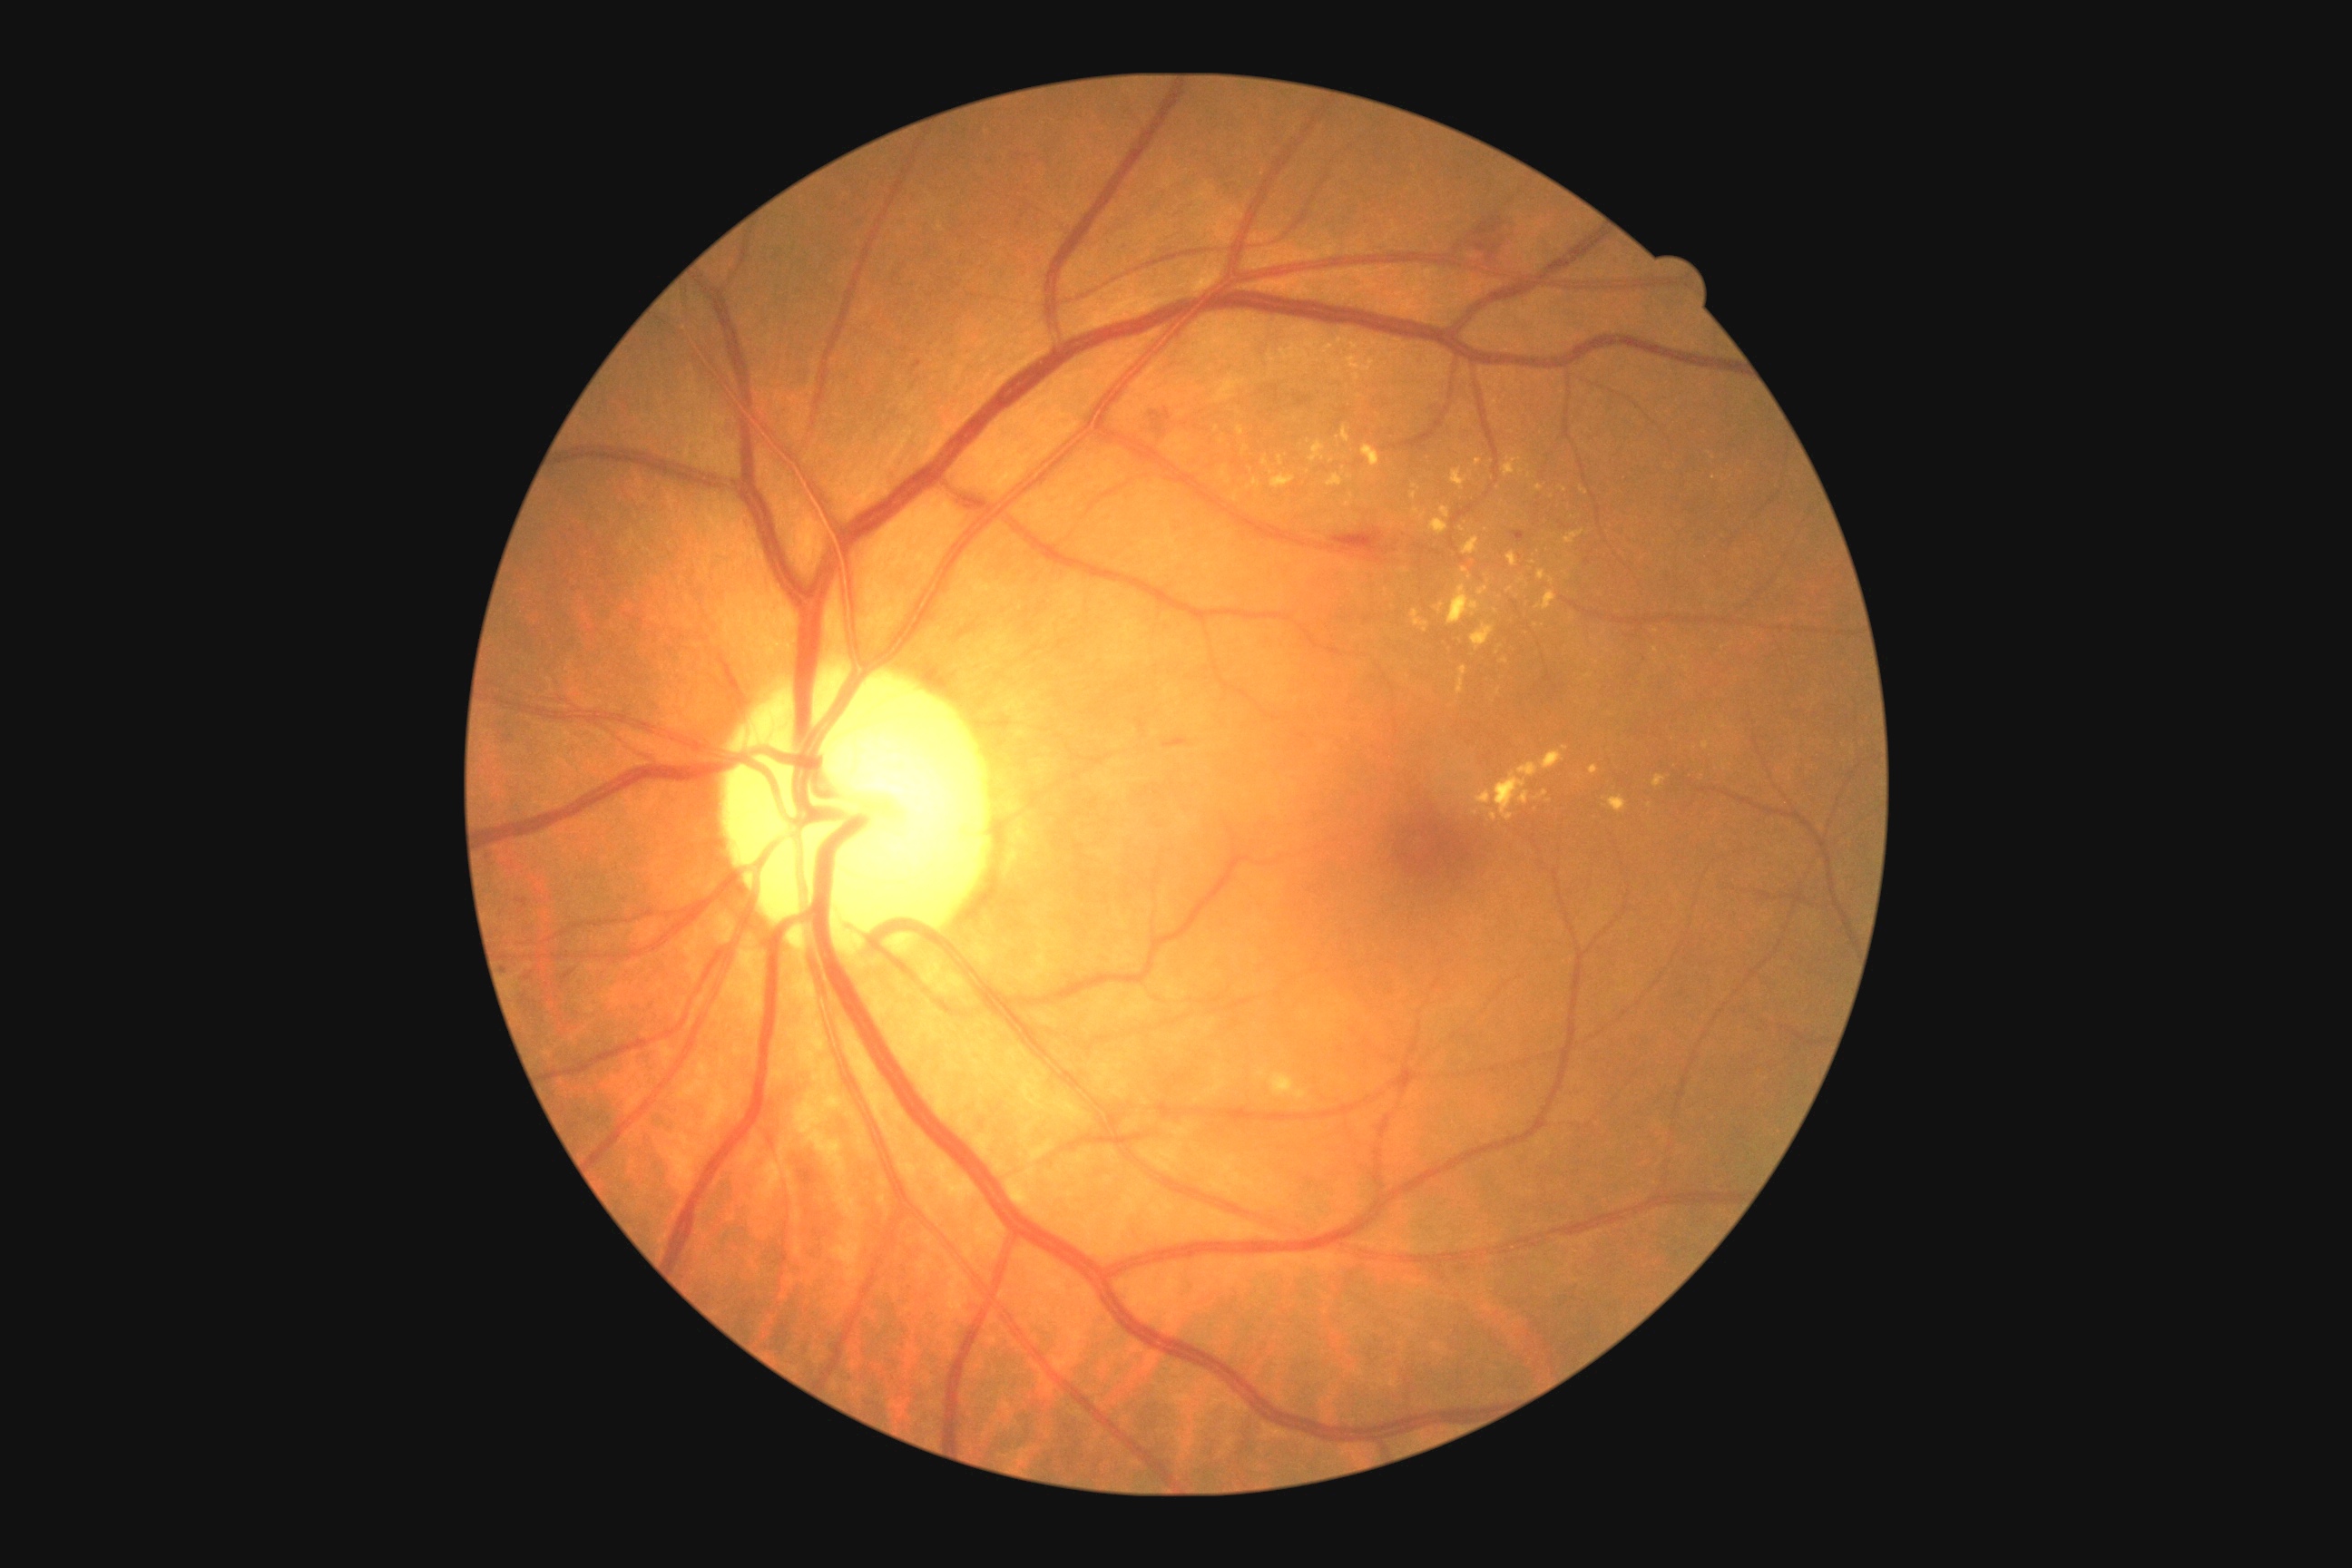

{
  "dr_grade": "2 — more than just microaneurysms but less than severe NPDR",
  "dr_category": "non-proliferative diabetic retinopathy"
}